Diabetic retinopathy graded by the modified Davis classification · NIDEK AFC-230 fundus camera · 848x848px · 45° field of view · color fundus photograph: 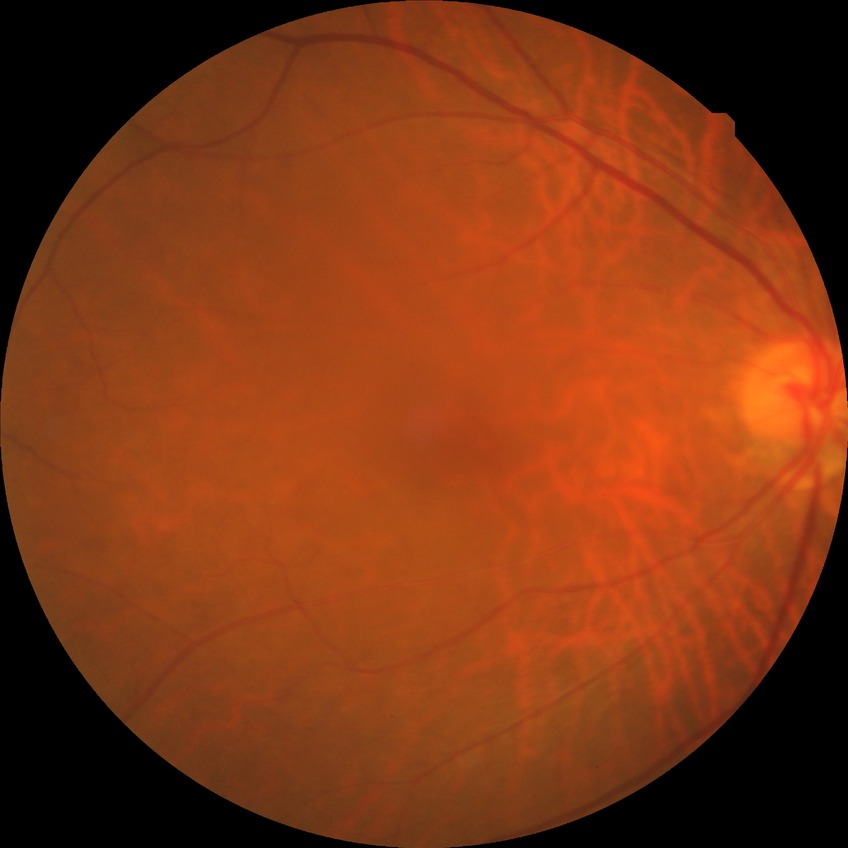
  davis_grade: no diabetic retinopathy